Modified Davis grading · posterior pole photograph: 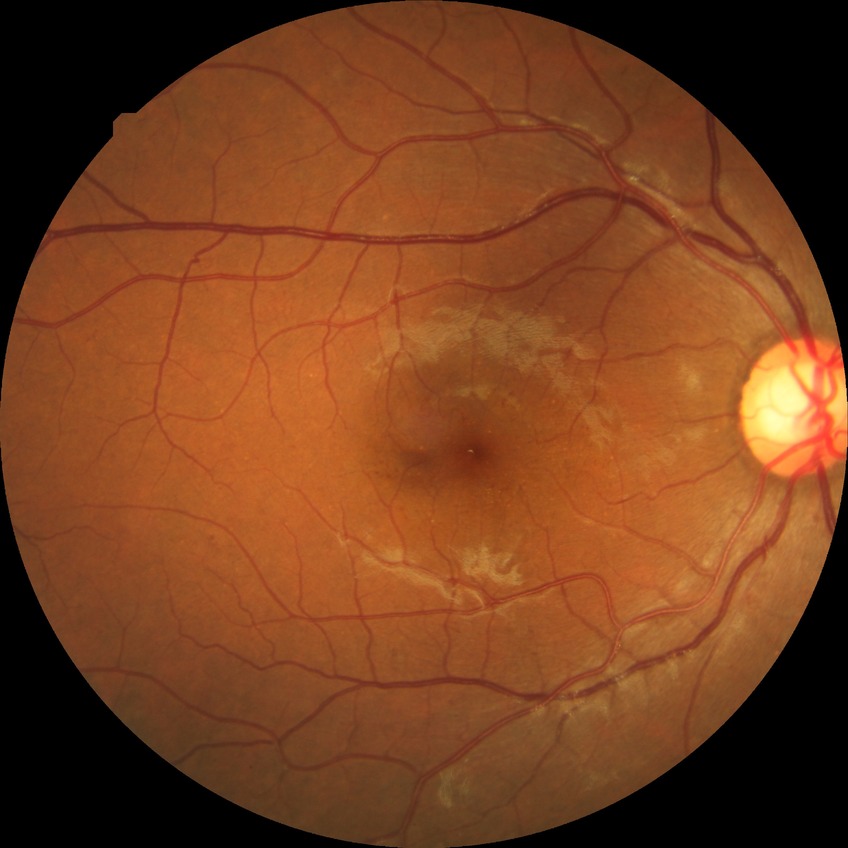
retinopathy grade: pre-proliferative diabetic retinopathy.